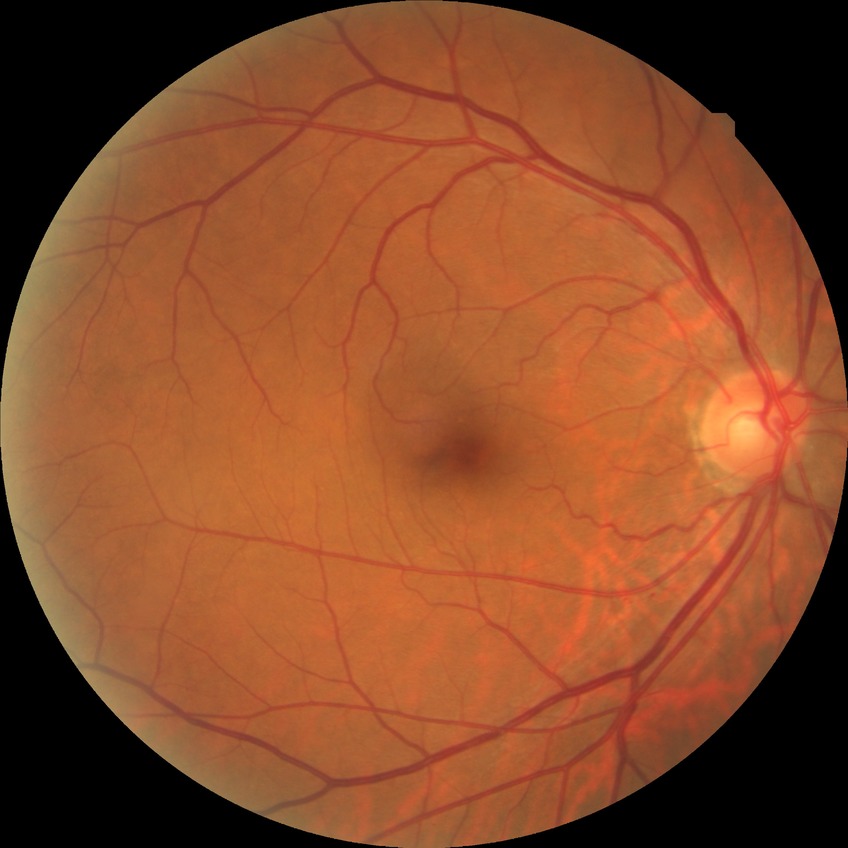 Assessment:
- Davis grade: NDR